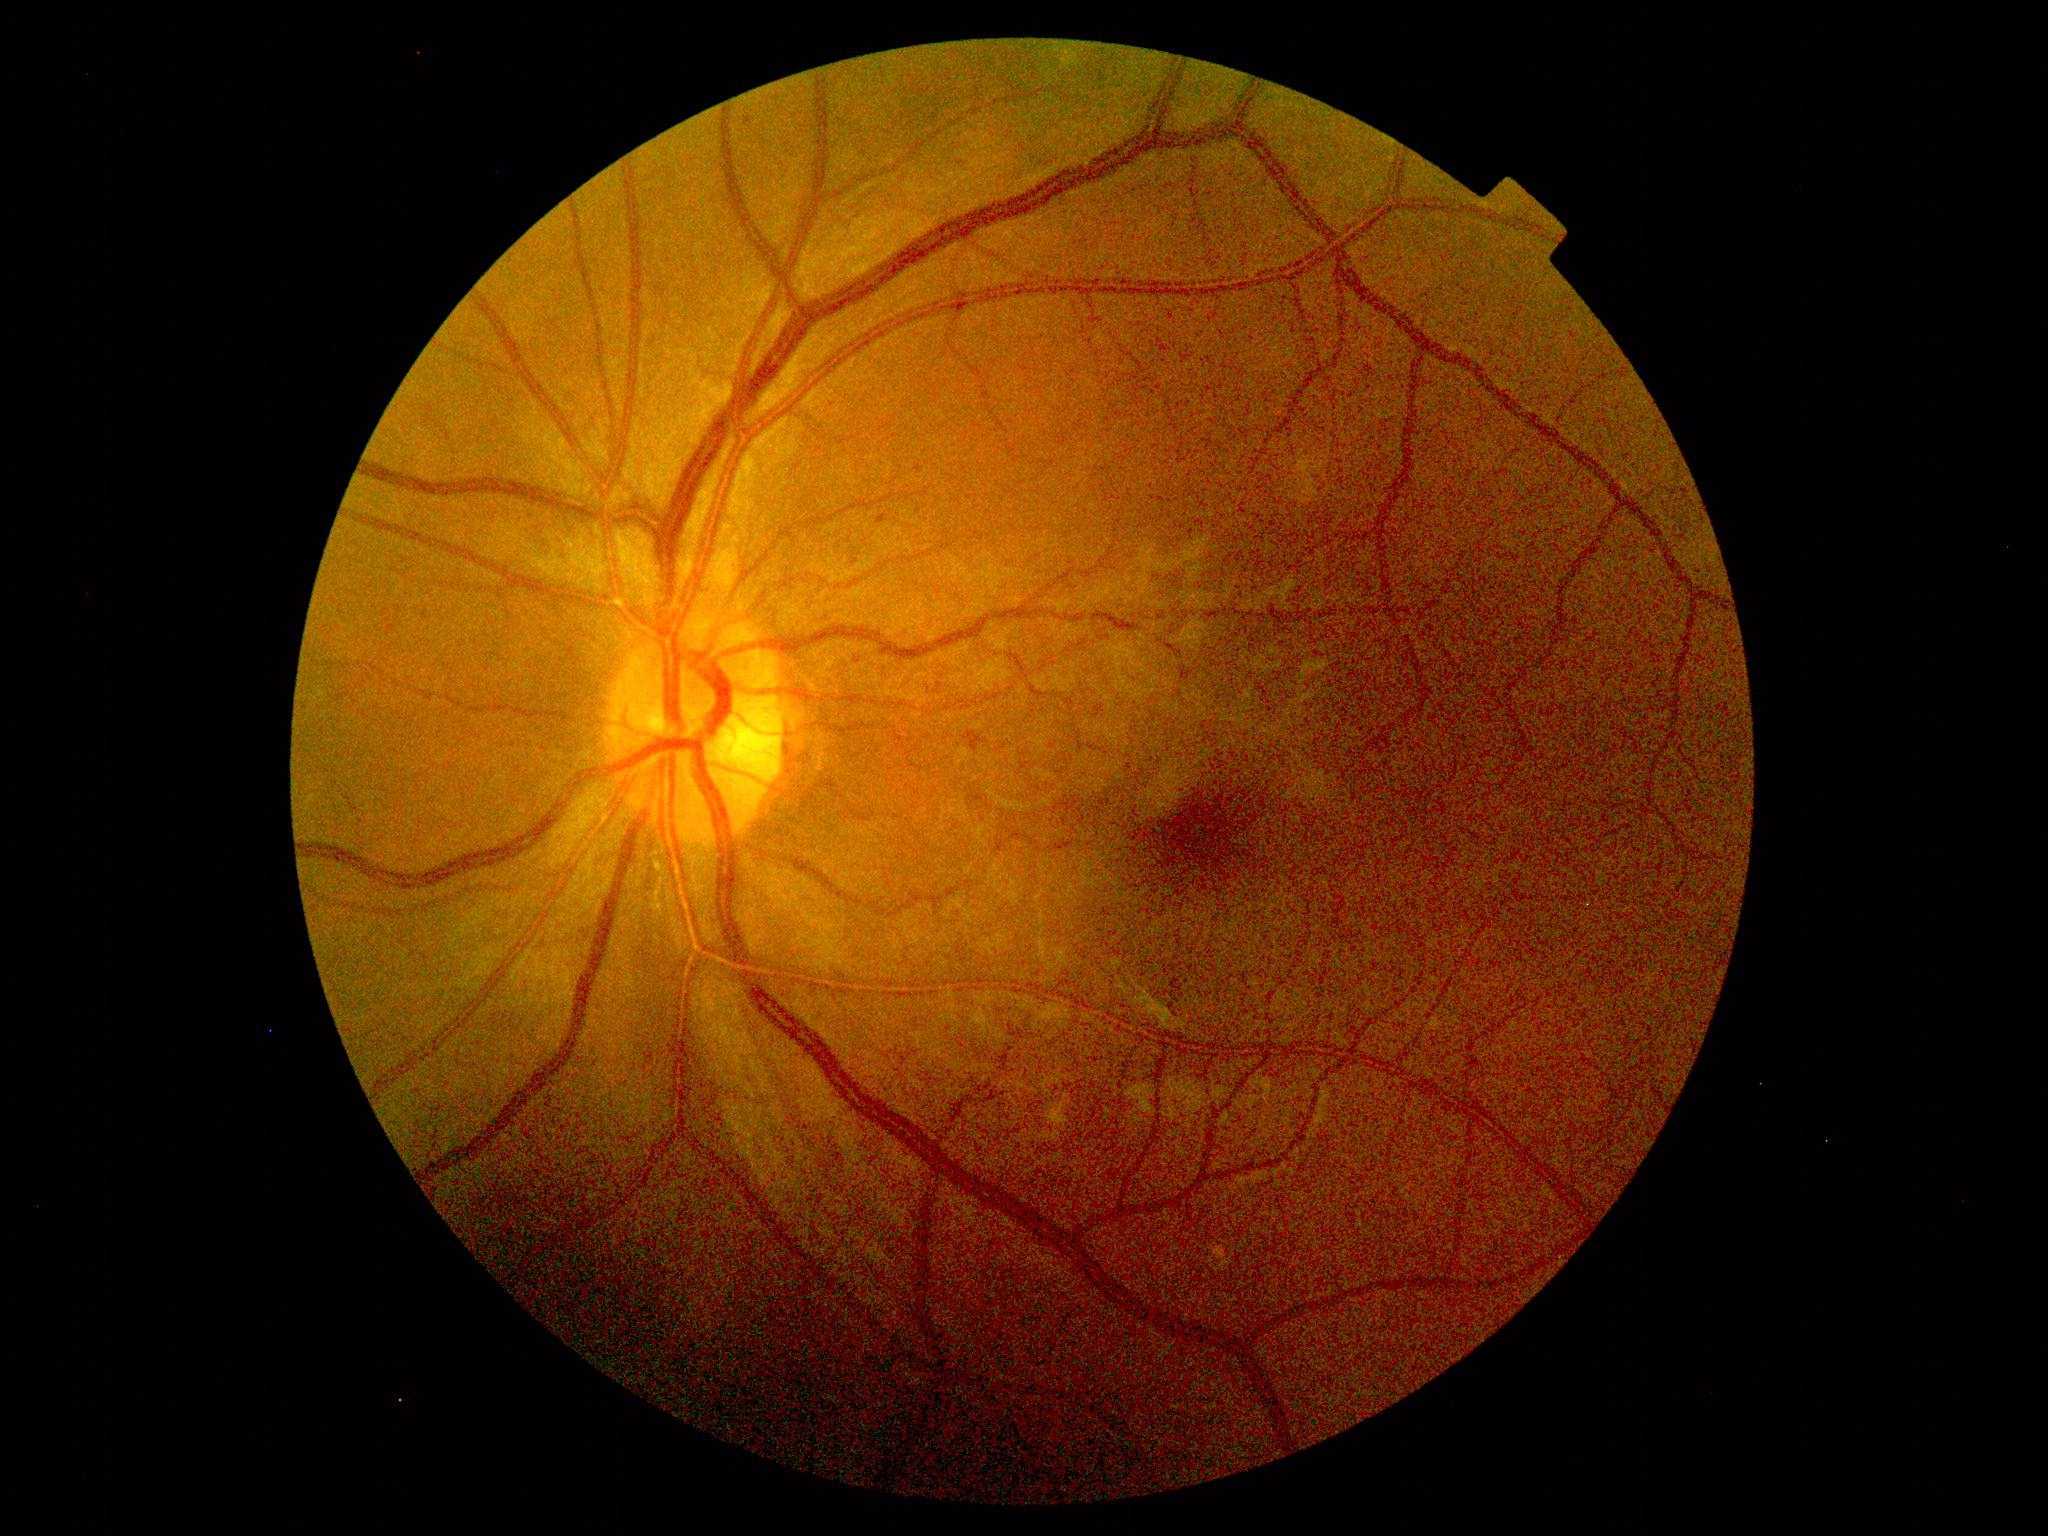
Findings:
* diabetic retinopathy (DR): 1/4